640 by 480 pixels. Acquired on the Clarity RetCam 3. Wide-field fundus photograph from neonatal ROP screening — 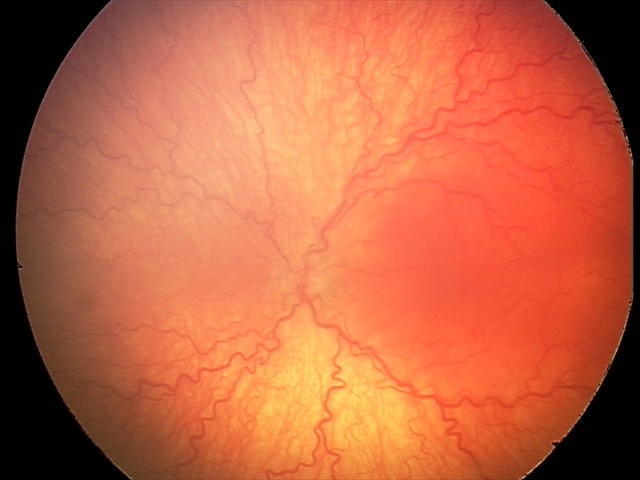
Diagnosis from this screening exam: aggressive retinopathy of prematurity.
With plus disease.